240x240:
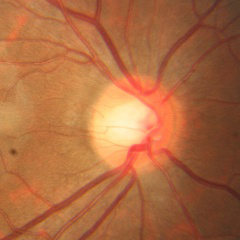 Glaucoma assessment = no evidence of glaucoma.